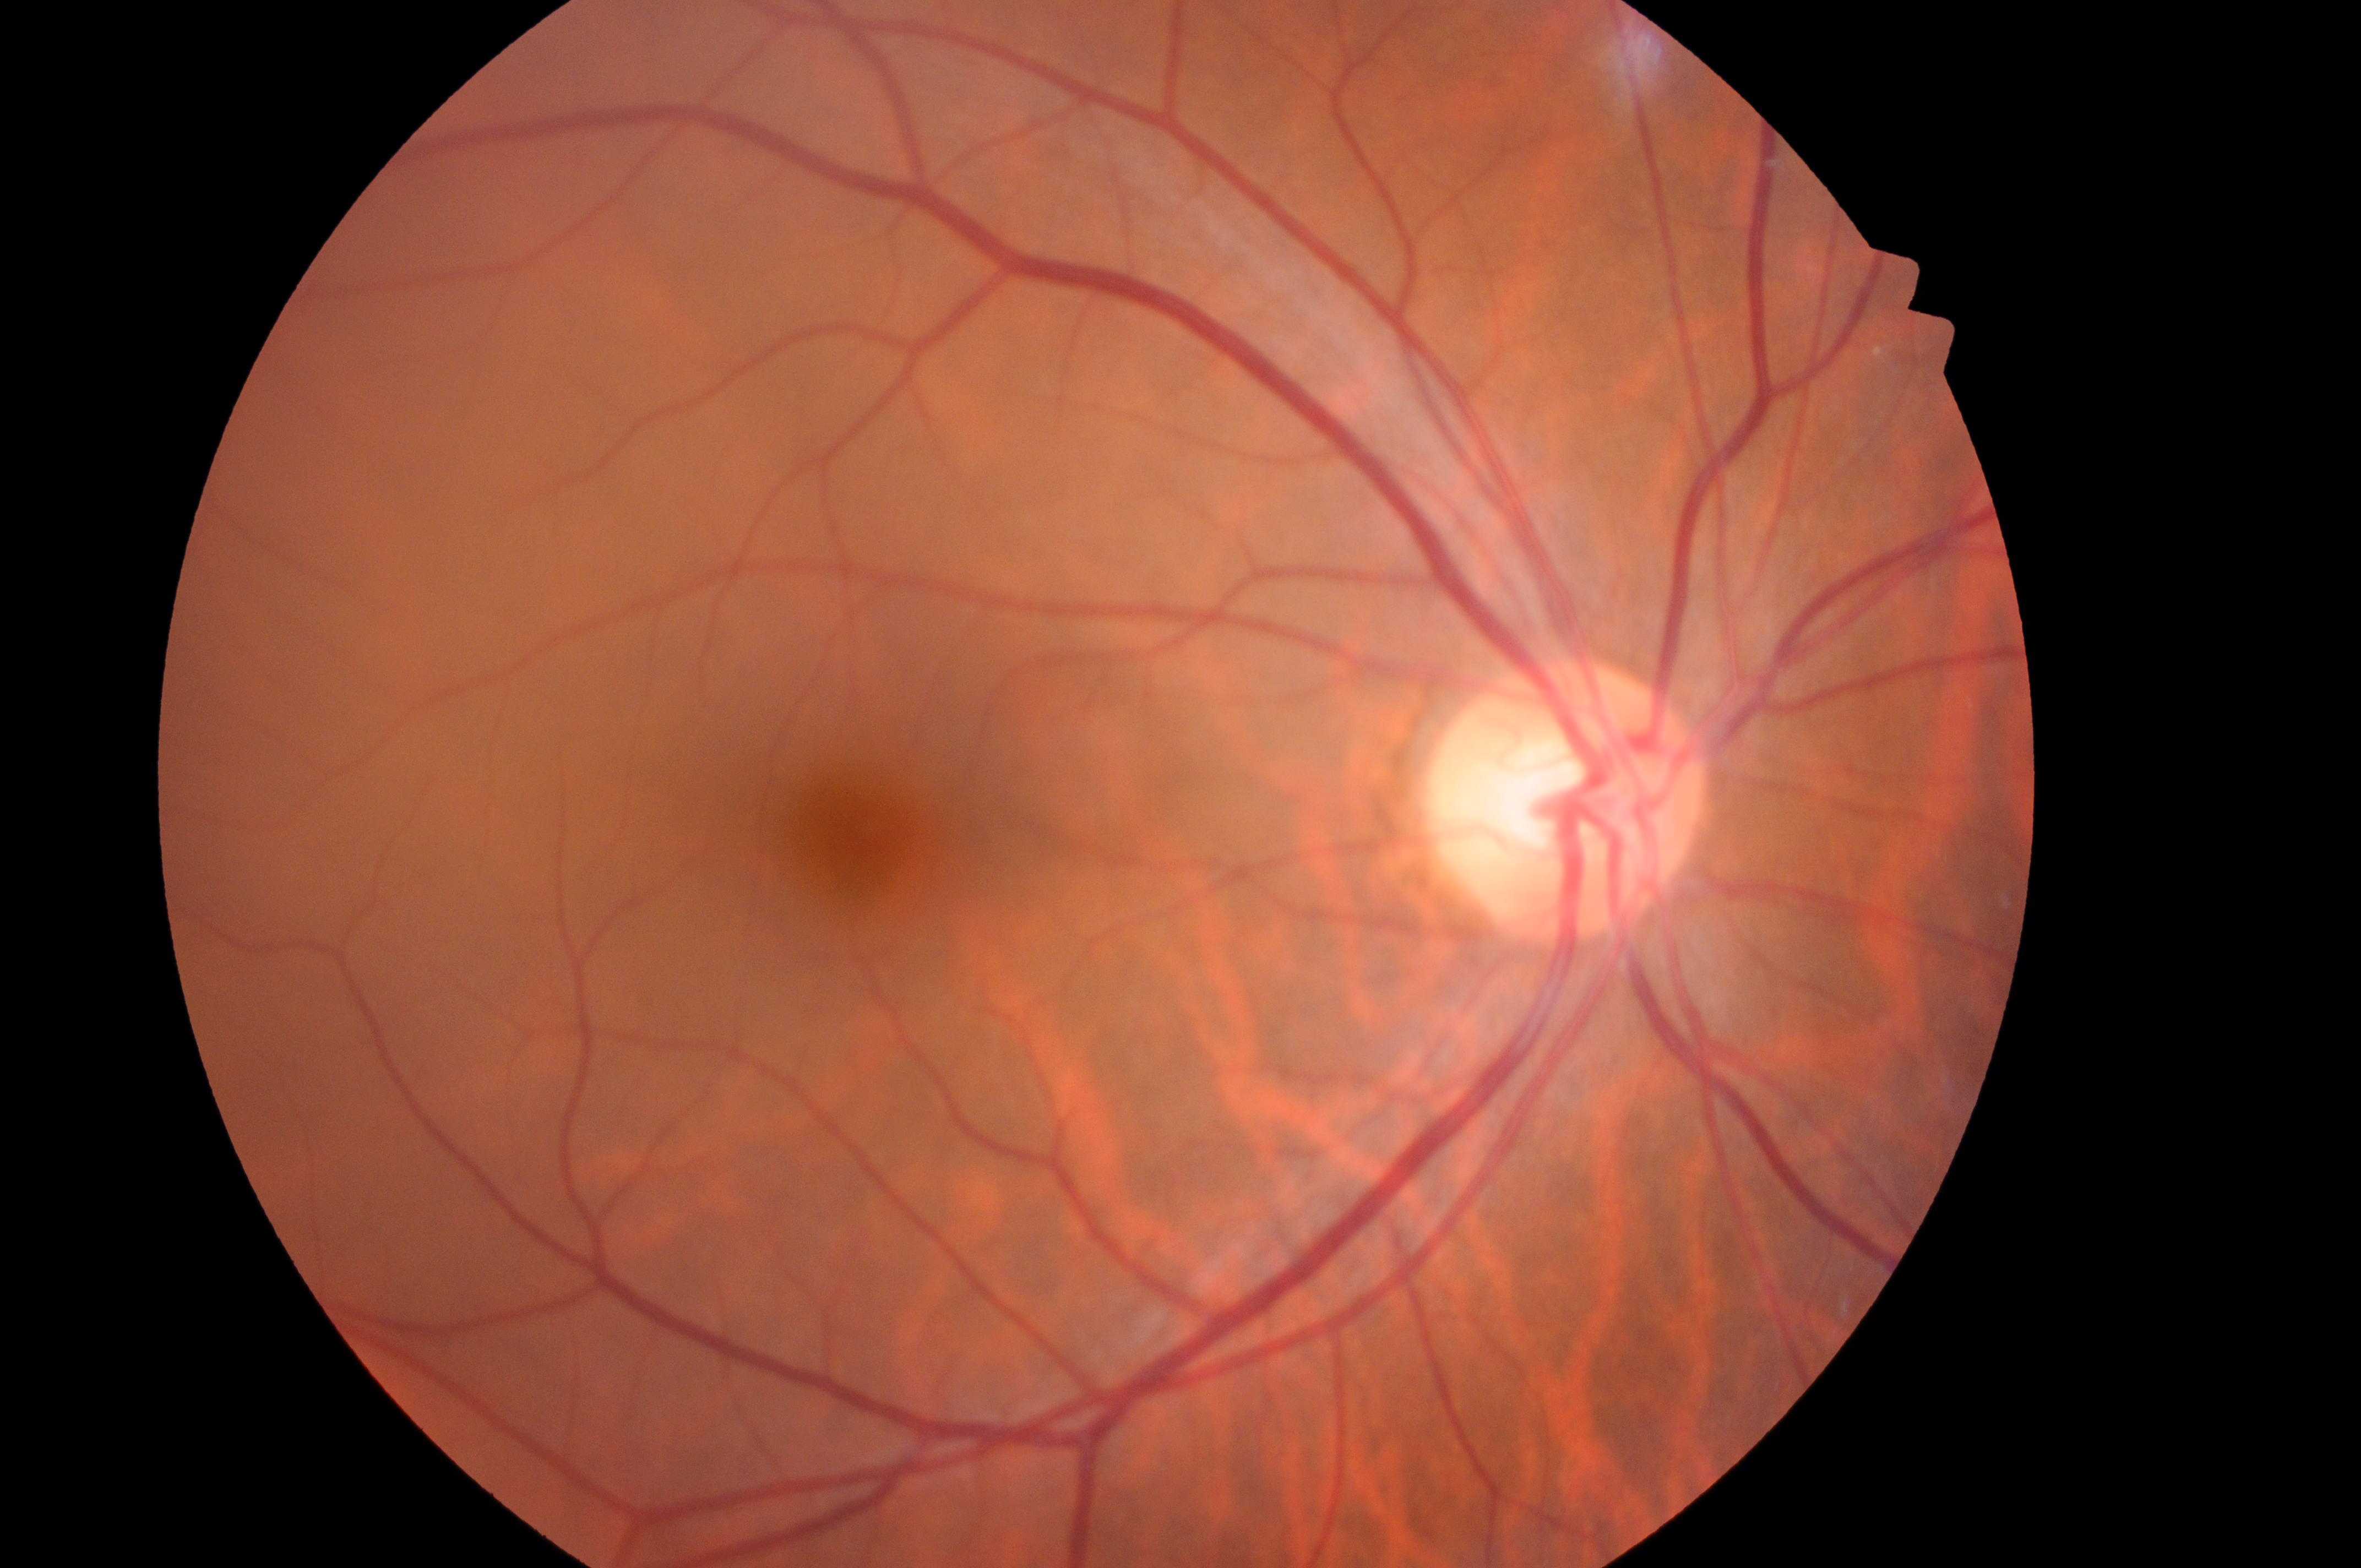 DR is no apparent retinopathy (grade 0). This is the right eye. Fovea: (858,835). The optic disc is at (1562,806). DME risk is no risk (grade 0).